Wide-field contact fundus photograph of an infant · camera: Clarity RetCam 3 (130° FOV):
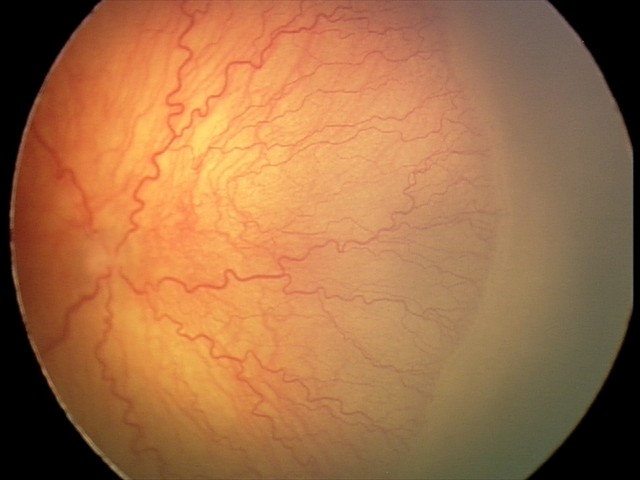 Finding: A-ROP (aggressive ROP).